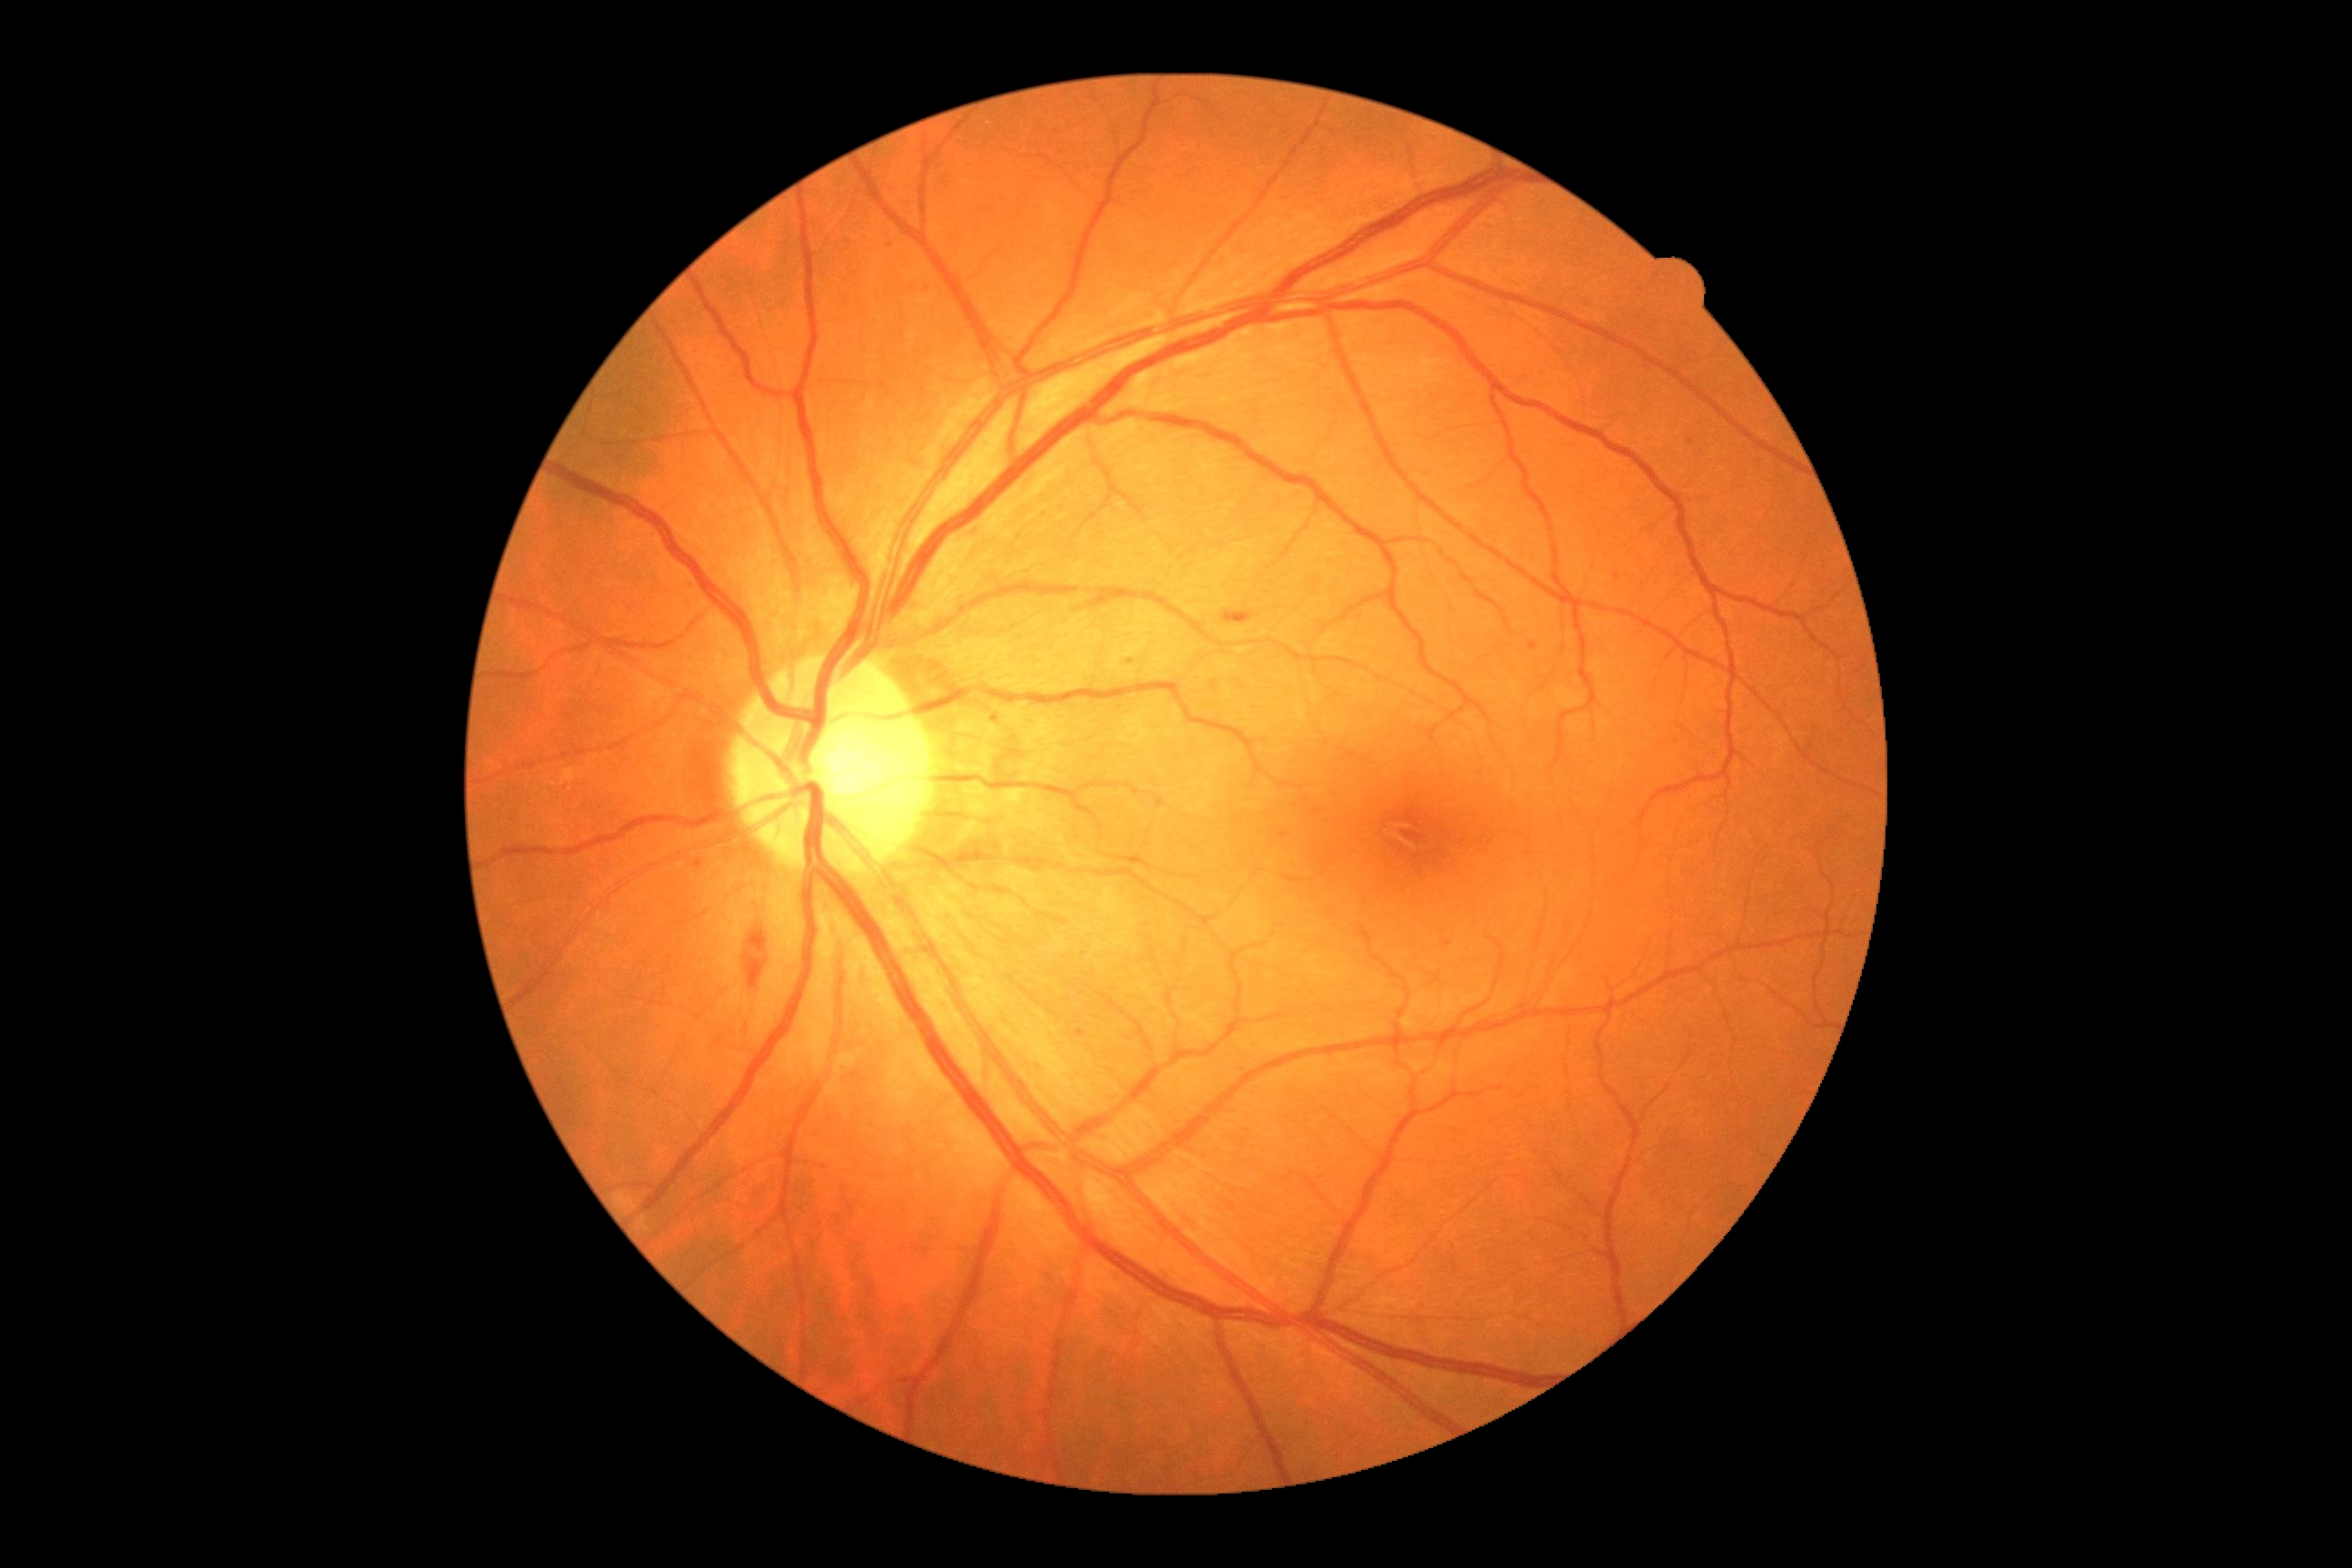

Findings:
- diabetic retinopathy (DR): moderate non-proliferative diabetic retinopathy (grade 2) — more than just microaneurysms but less than severe NPDR